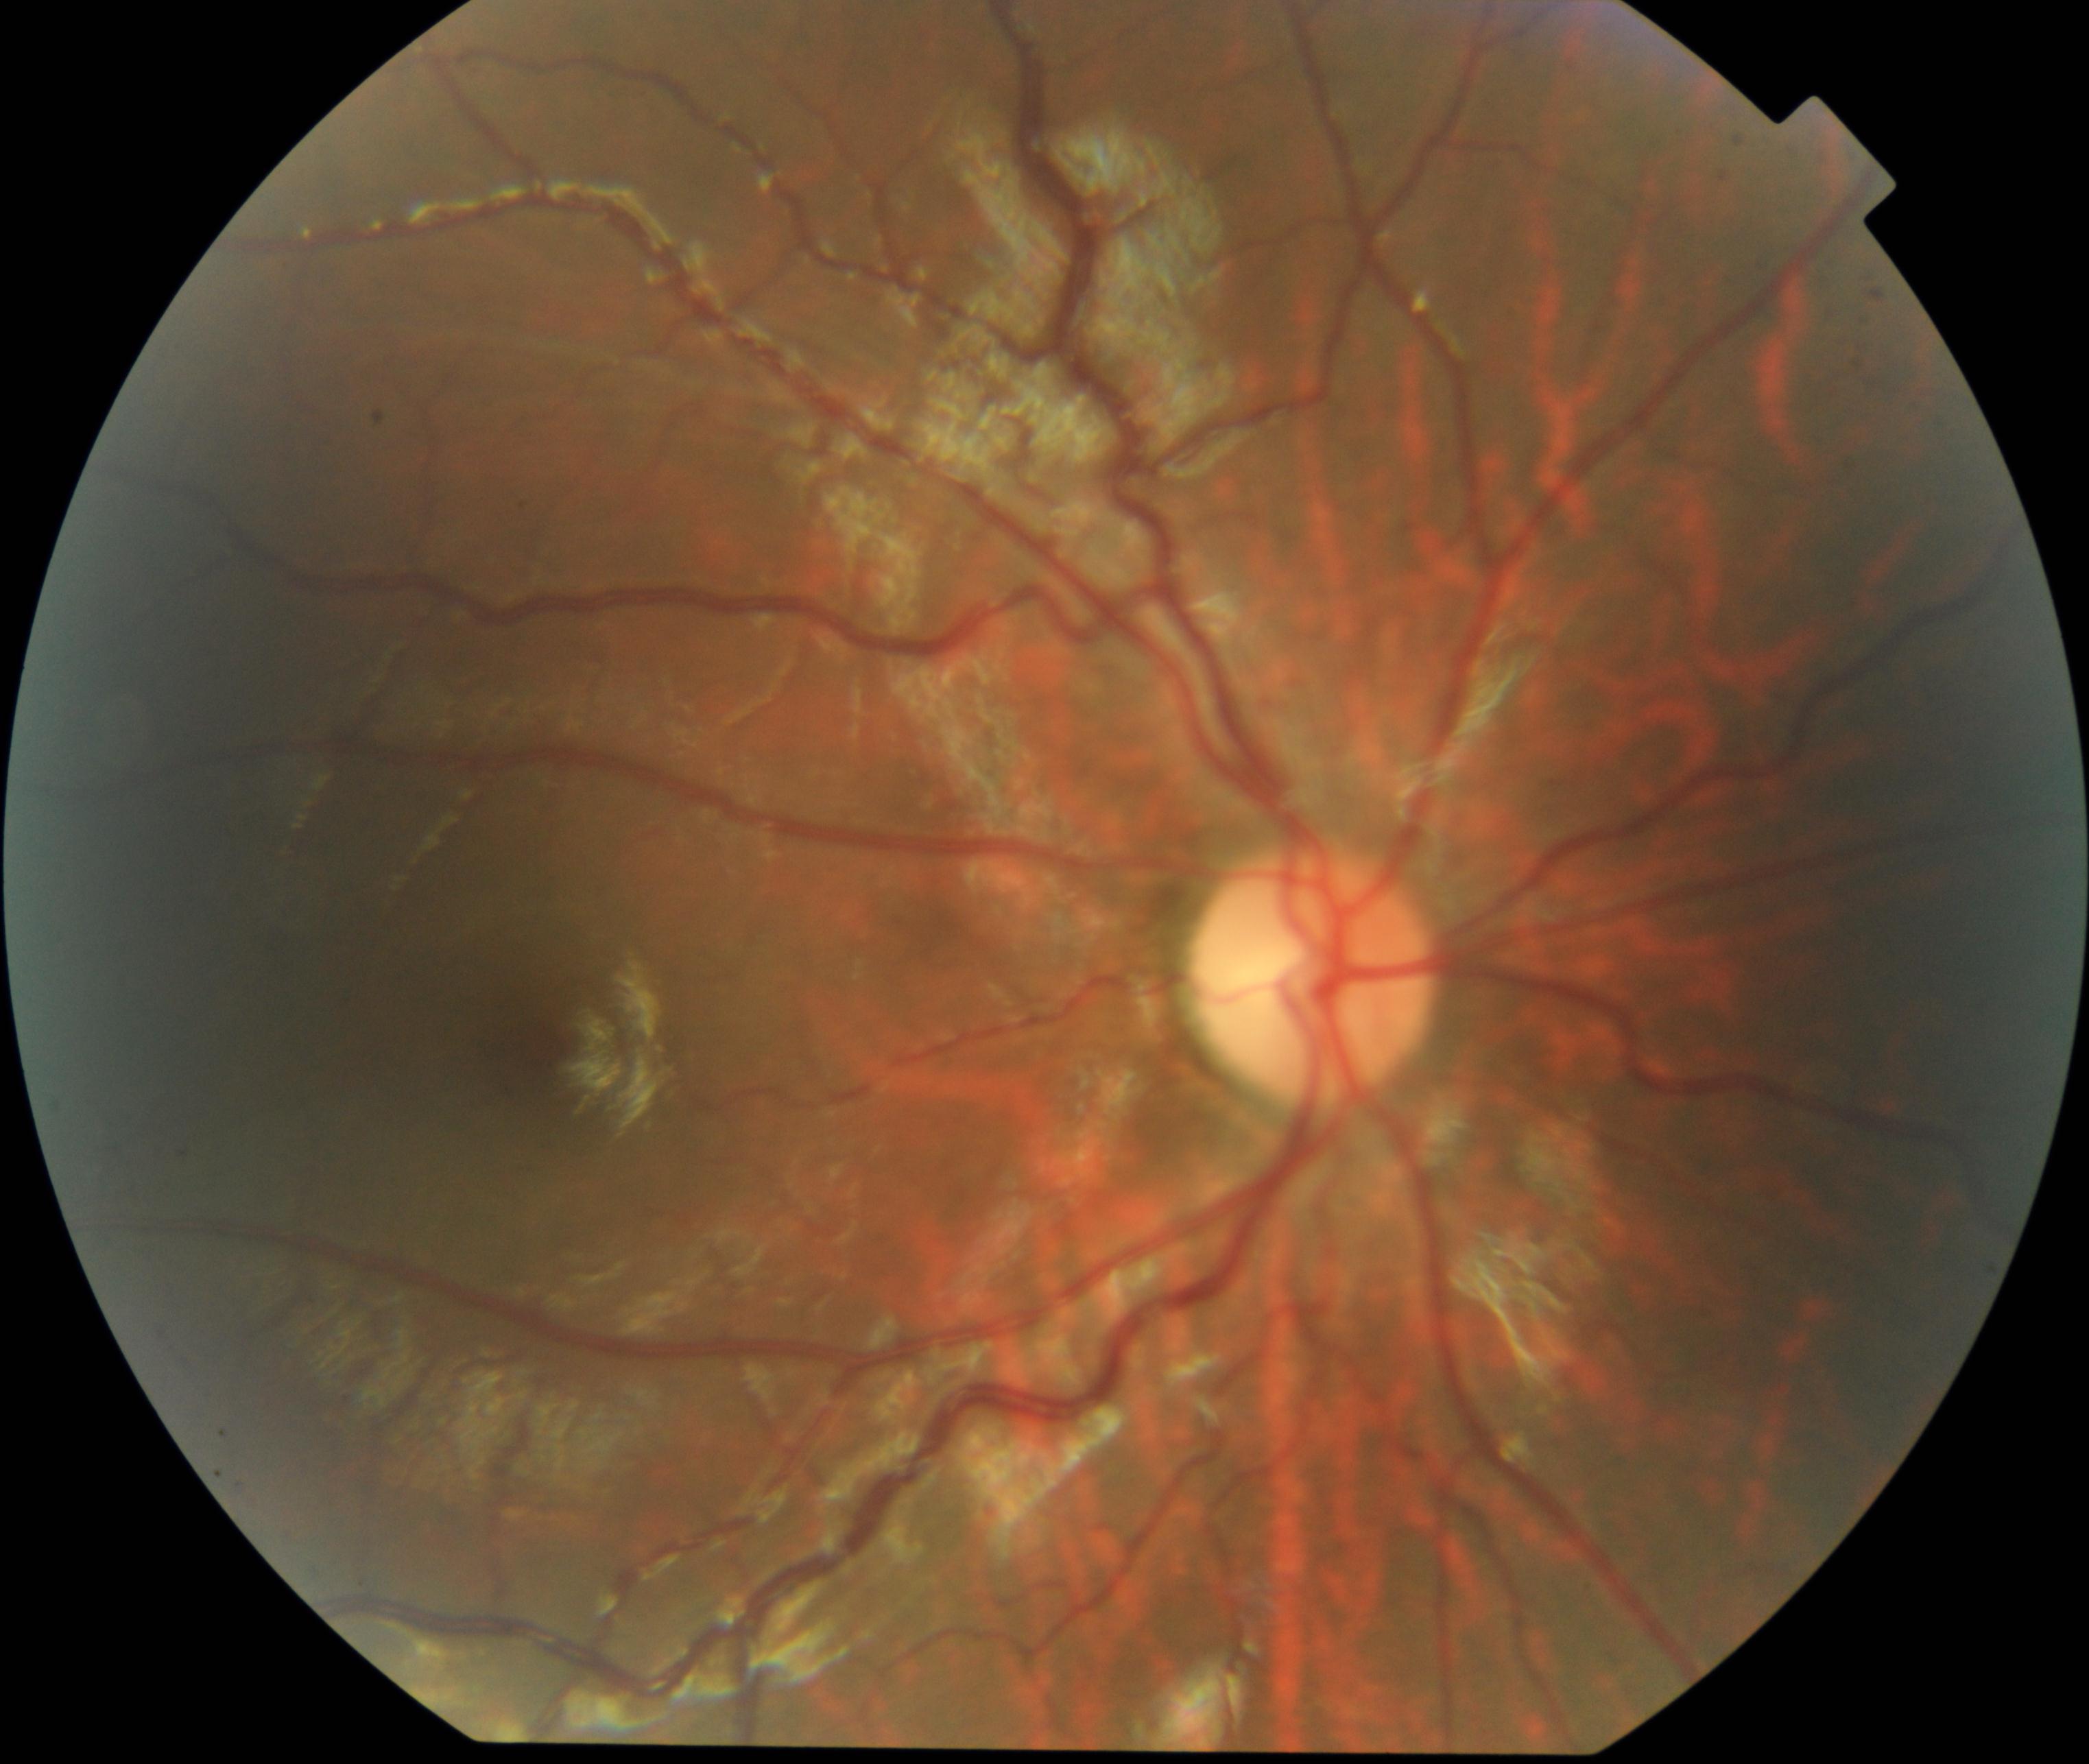 The image shows vessel tortuosity.